1924x1556, wide-field retinal mosaic image
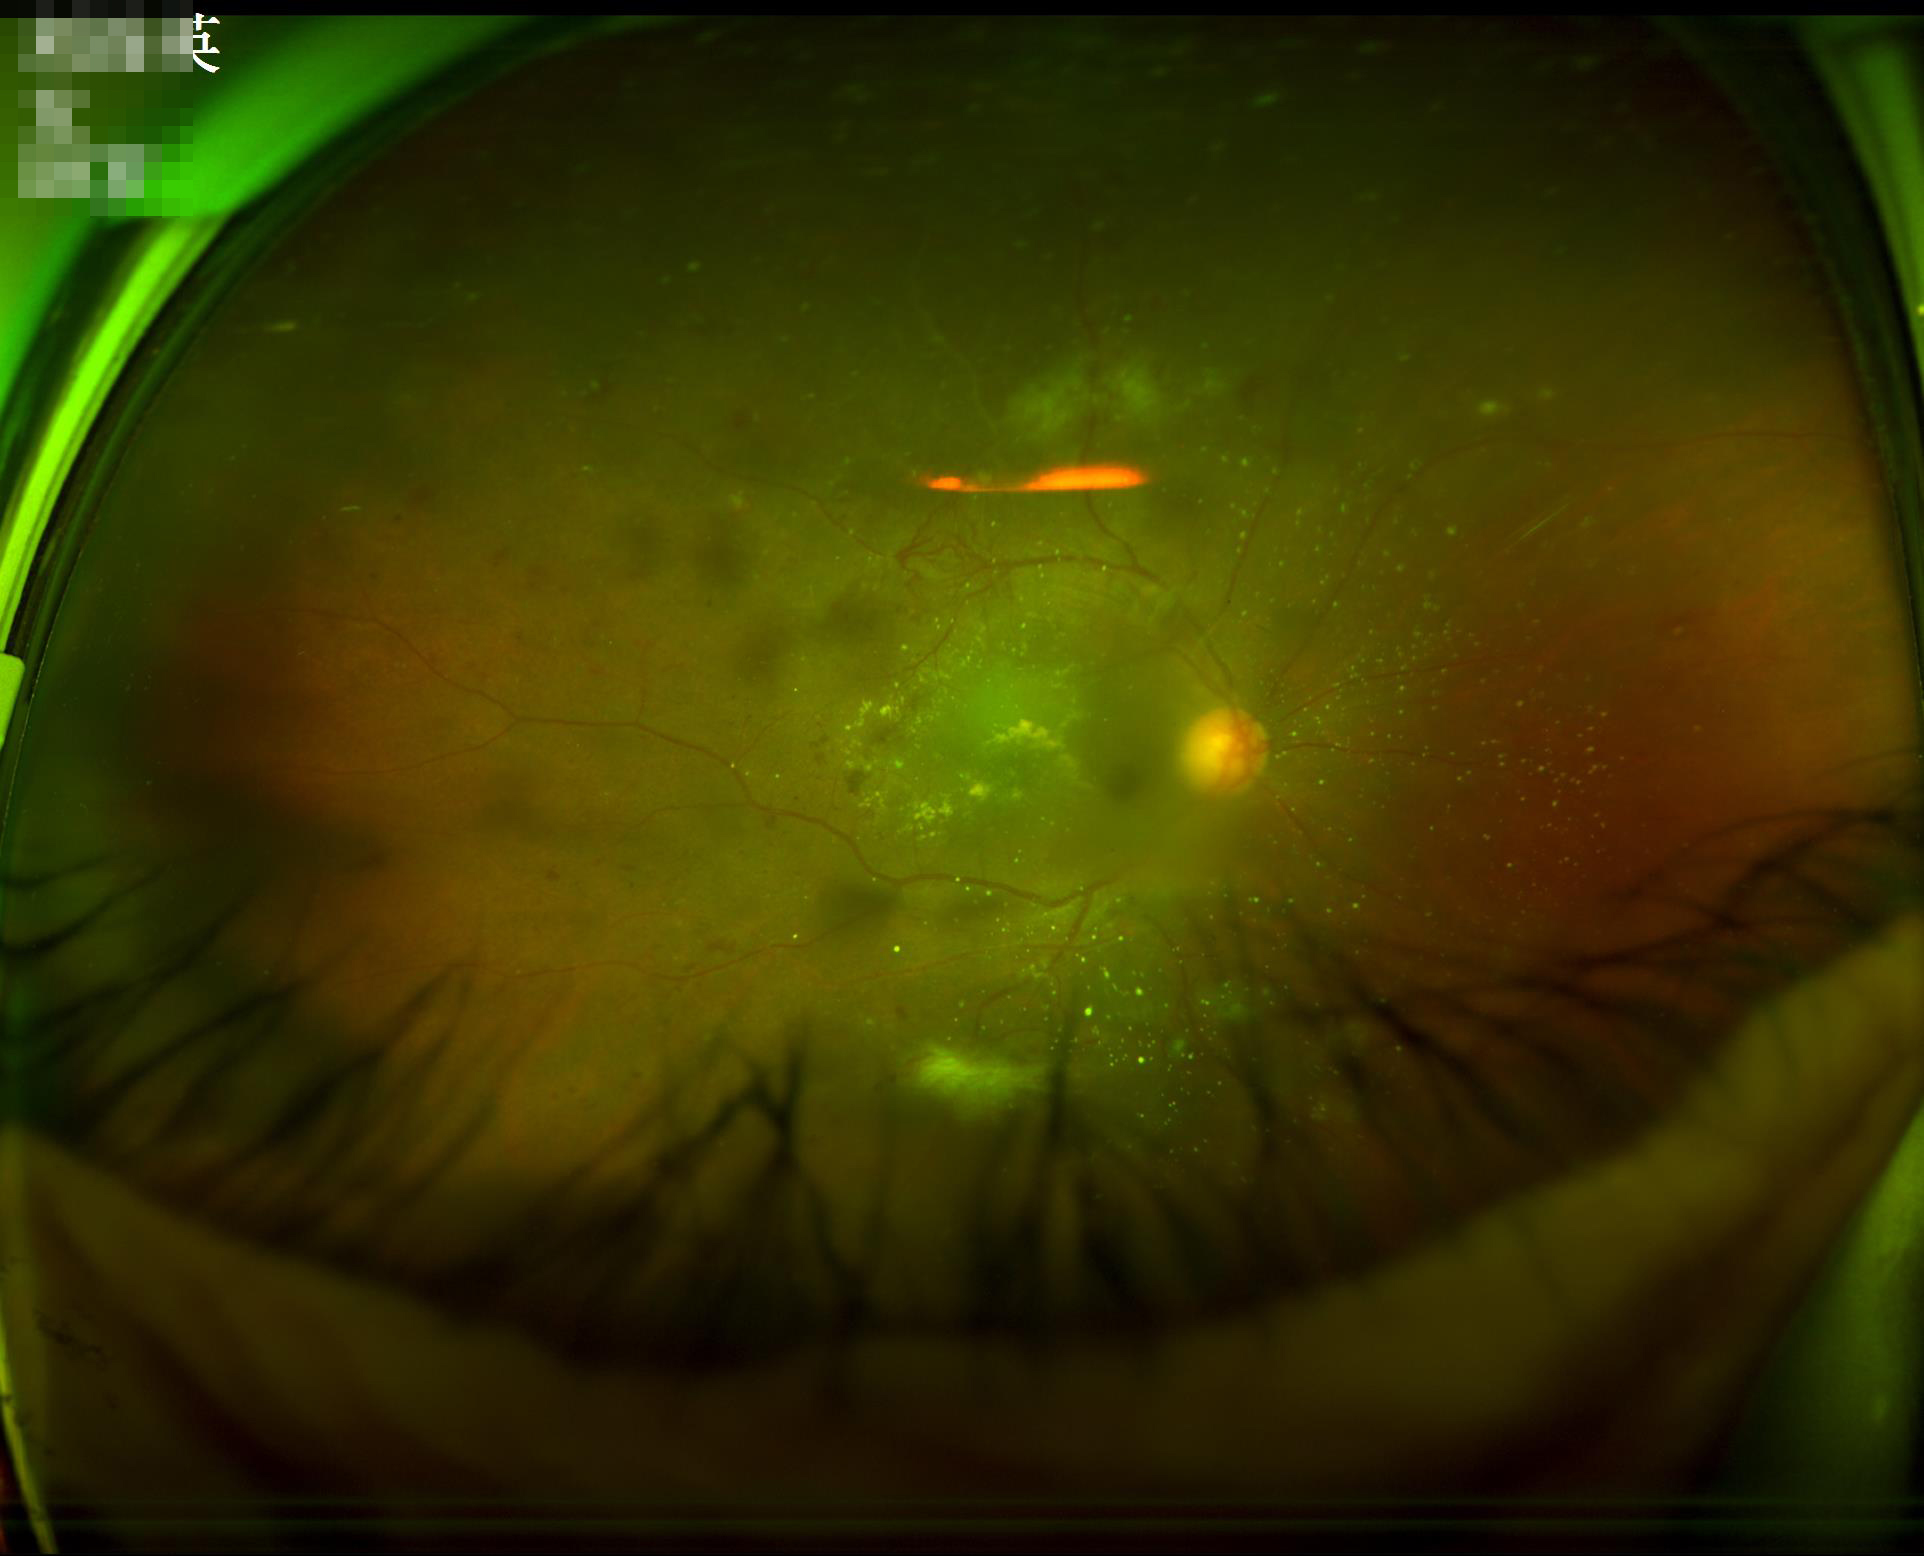

Overall = poor | Contrast = adequate | Illumination/color = poor | Focus = out of focus.